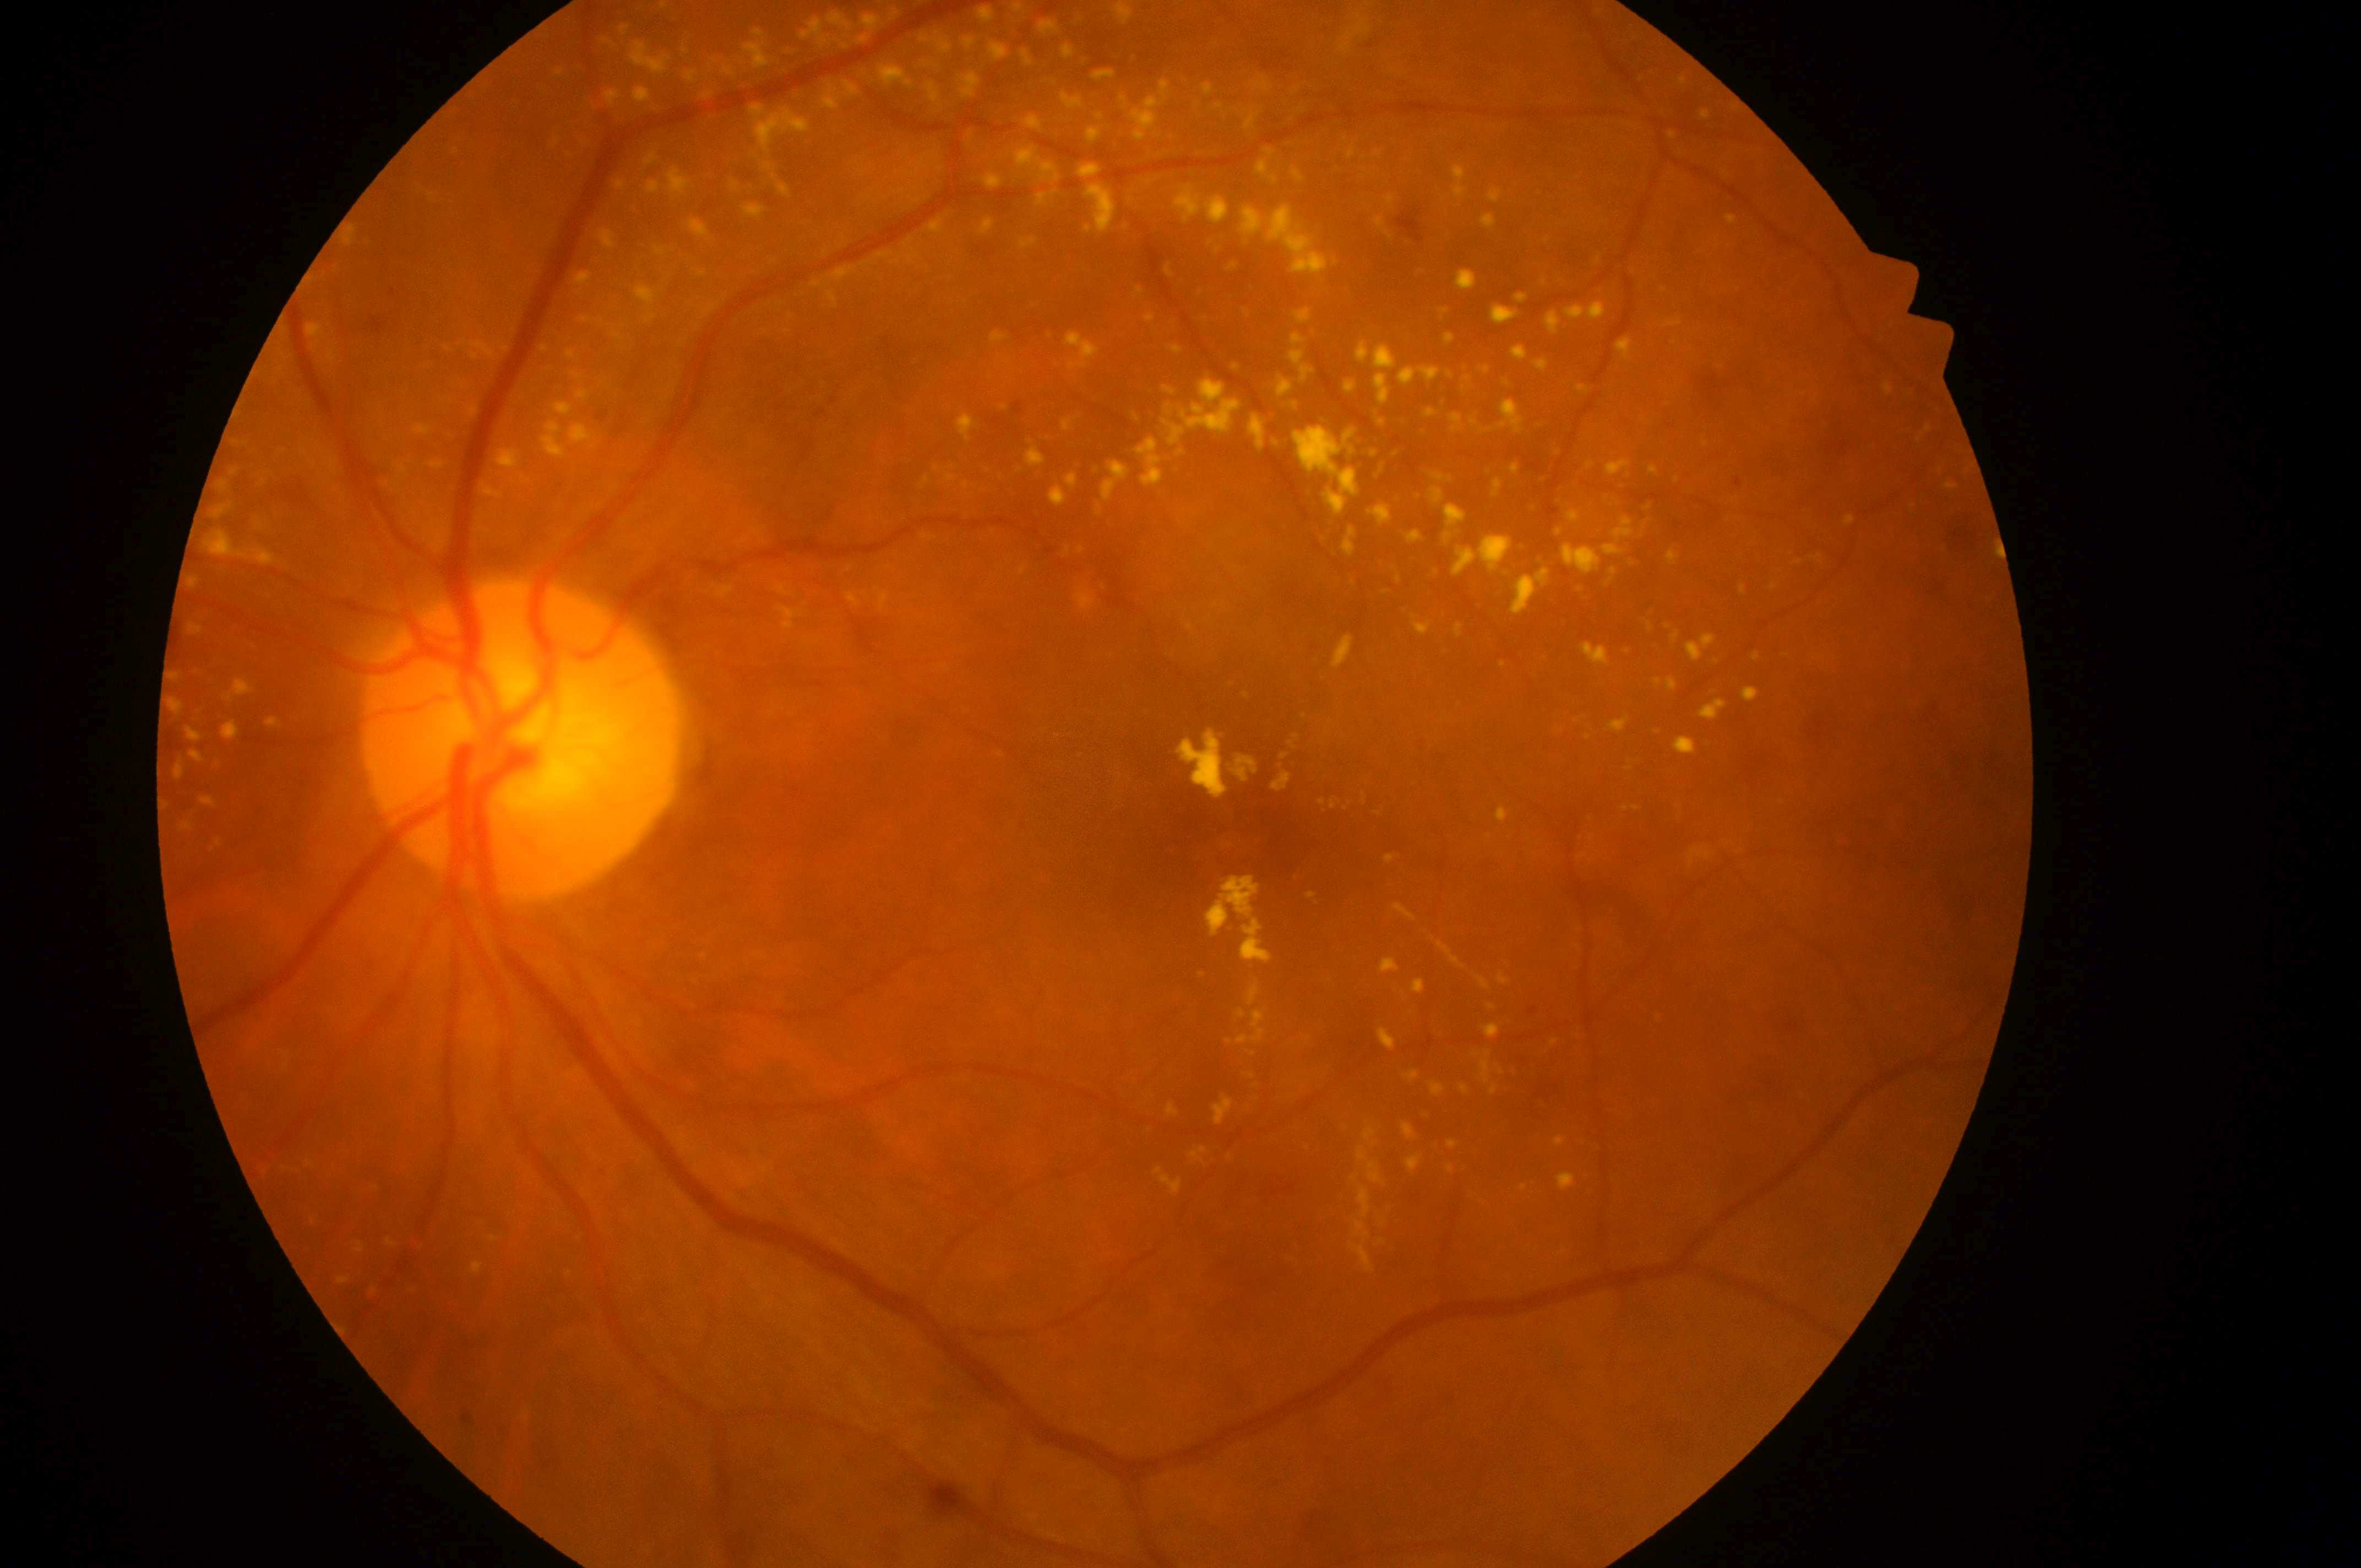

Retinopathy: moderate NPDR (grade 2). The fovea is at (x=1230, y=839). Imaged eye: left. Risk of diabetic macular edema is grade 2 (high risk). Optic disk located at (x=518, y=748).